Acquired on the Clarity RetCam 3 · pediatric retinal photograph (wide-field) · 640x480px:
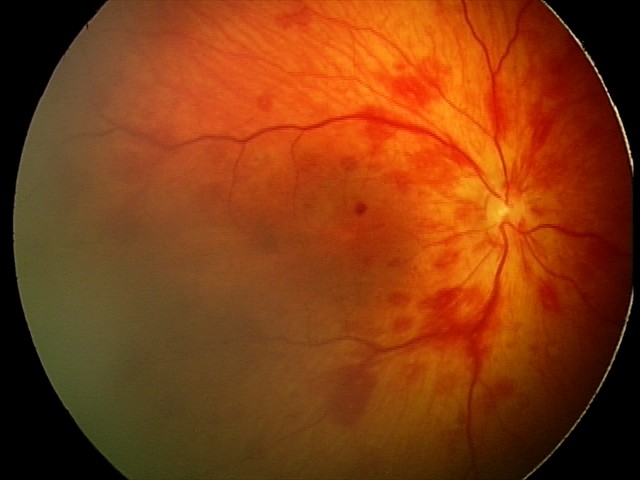
Screening series with retinal hemorrhages.